FOV: 45 degrees: 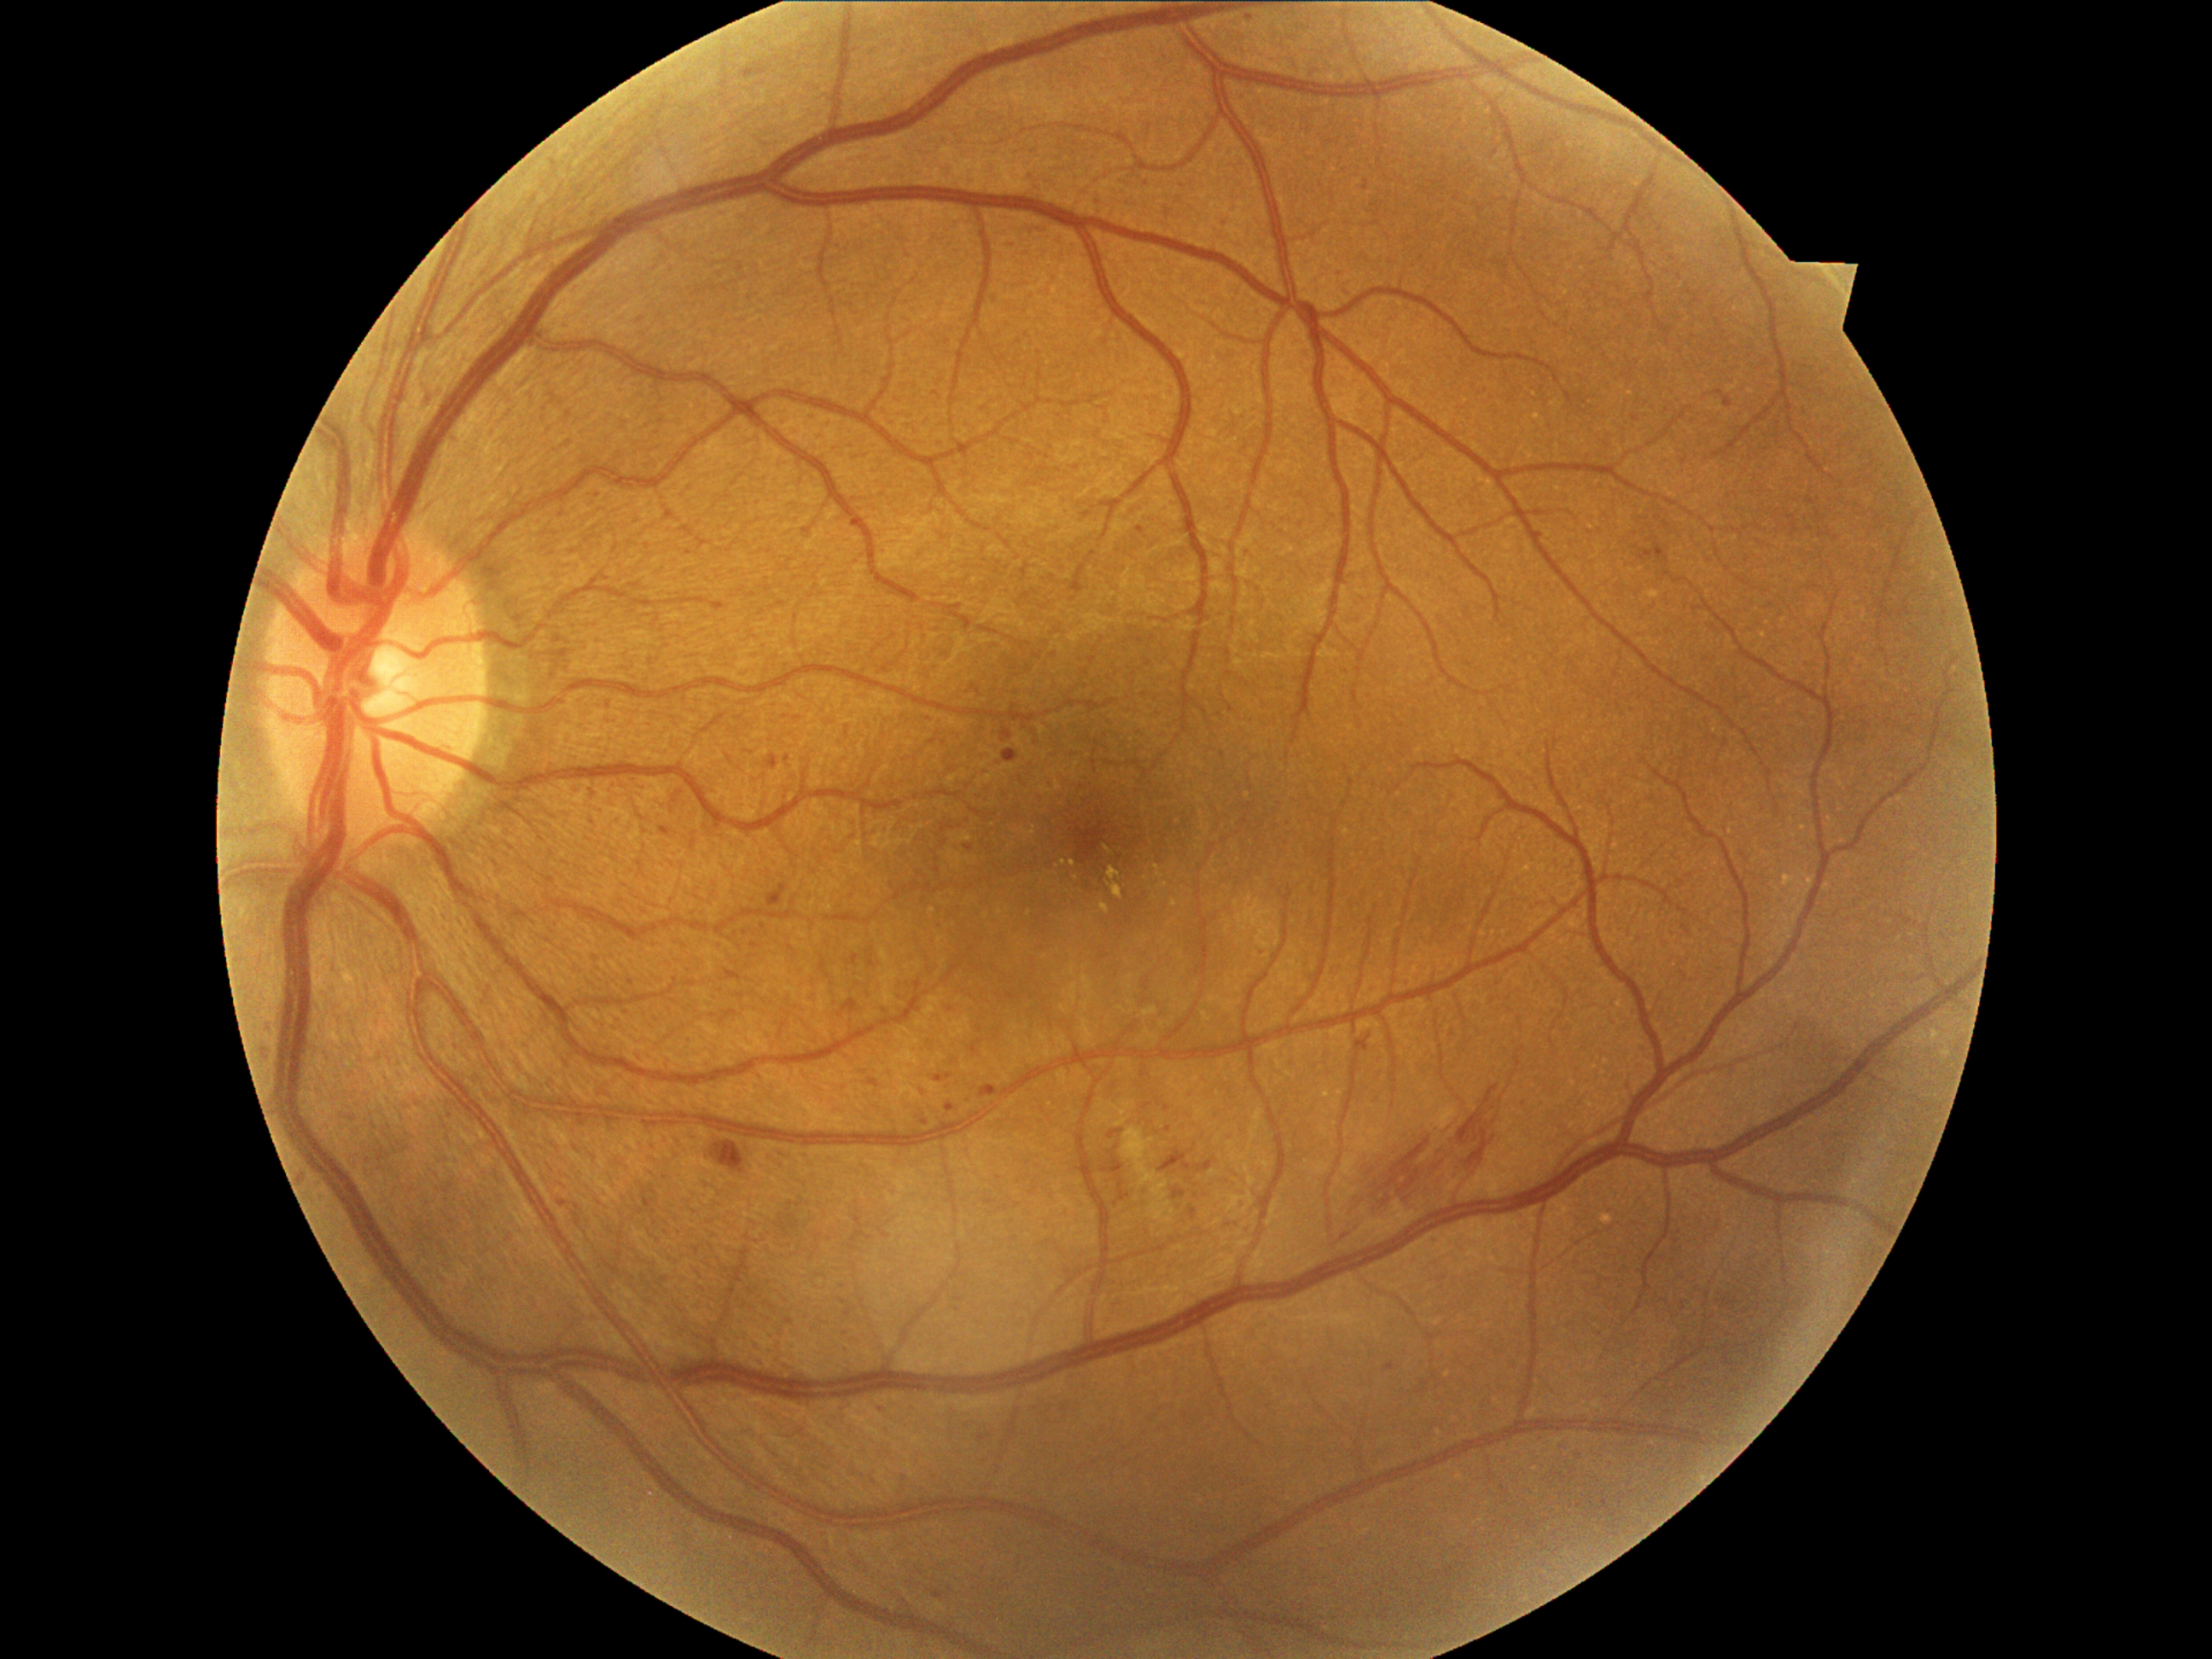
Diabetic retinopathy (DR) is grade 2
A subset of detected lesions:
microaneurysms (MAs) (subset): 1138, 527, 1144, 535 | 1189, 1208, 1197, 1220 | 1223, 218, 1228, 228 | 1003, 750, 1018, 762 | 769, 755, 779, 769 | 1718, 390, 1733, 409 | 264, 1022, 272, 1027 | 1578, 1448, 1583, 1460 | 842, 999, 859, 1013 | 1641, 552, 1653, 559 | 769, 885, 789, 907
Smaller MAs around 1167, 1109 | 1144, 1074 | 1147, 1106 | 562, 1204
soft exudates (SEs): 1150, 1180, 1173, 1225 | 1122, 1127, 1158, 1189
hemorrhages (HEs): 1356, 1035, 1373, 1052 | 1344, 1086, 1499, 1240 | 711, 1141, 745, 1173 | 1160, 1150, 1190, 1172
hard exudates (EXs): 1100, 904, 1112, 914 | 1109, 868, 1122, 880 | 1107, 882, 1124, 899
Smaller EXs around 1073, 864 | 1065, 863